1470x1137px
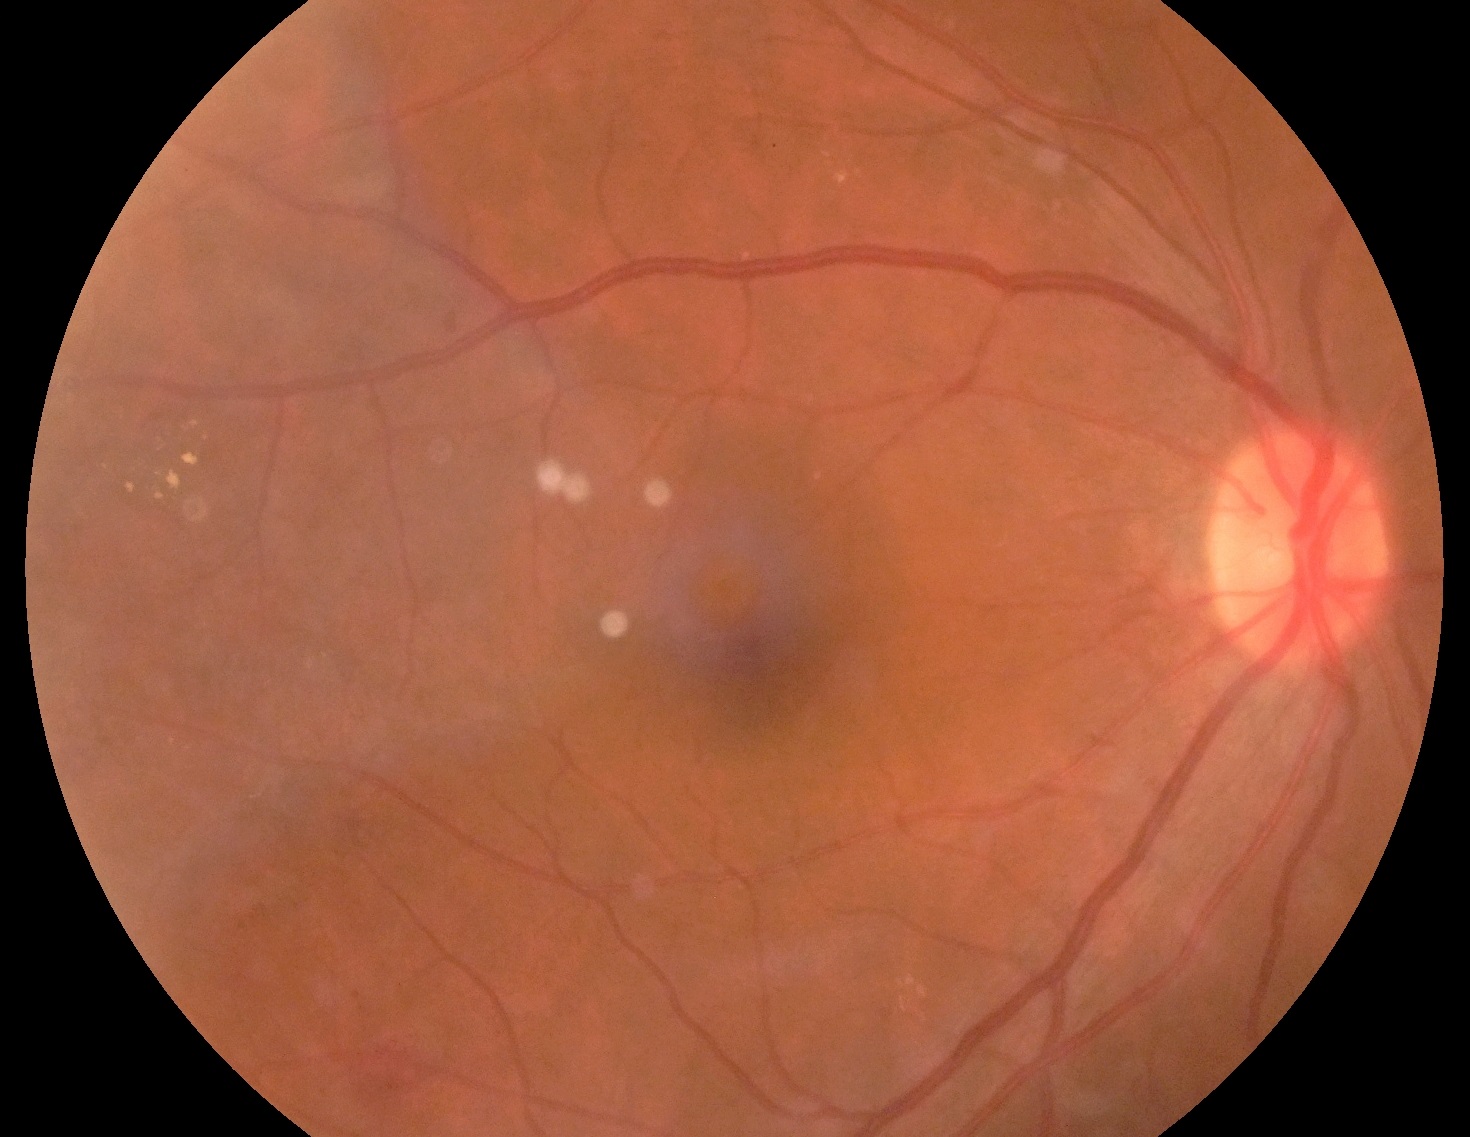

Diabetic retinopathy (DR) is grade 2 (moderate NPDR).